1659x2212. Retinal fundus photograph. Remidio Fundus on Phone (FOP) camera
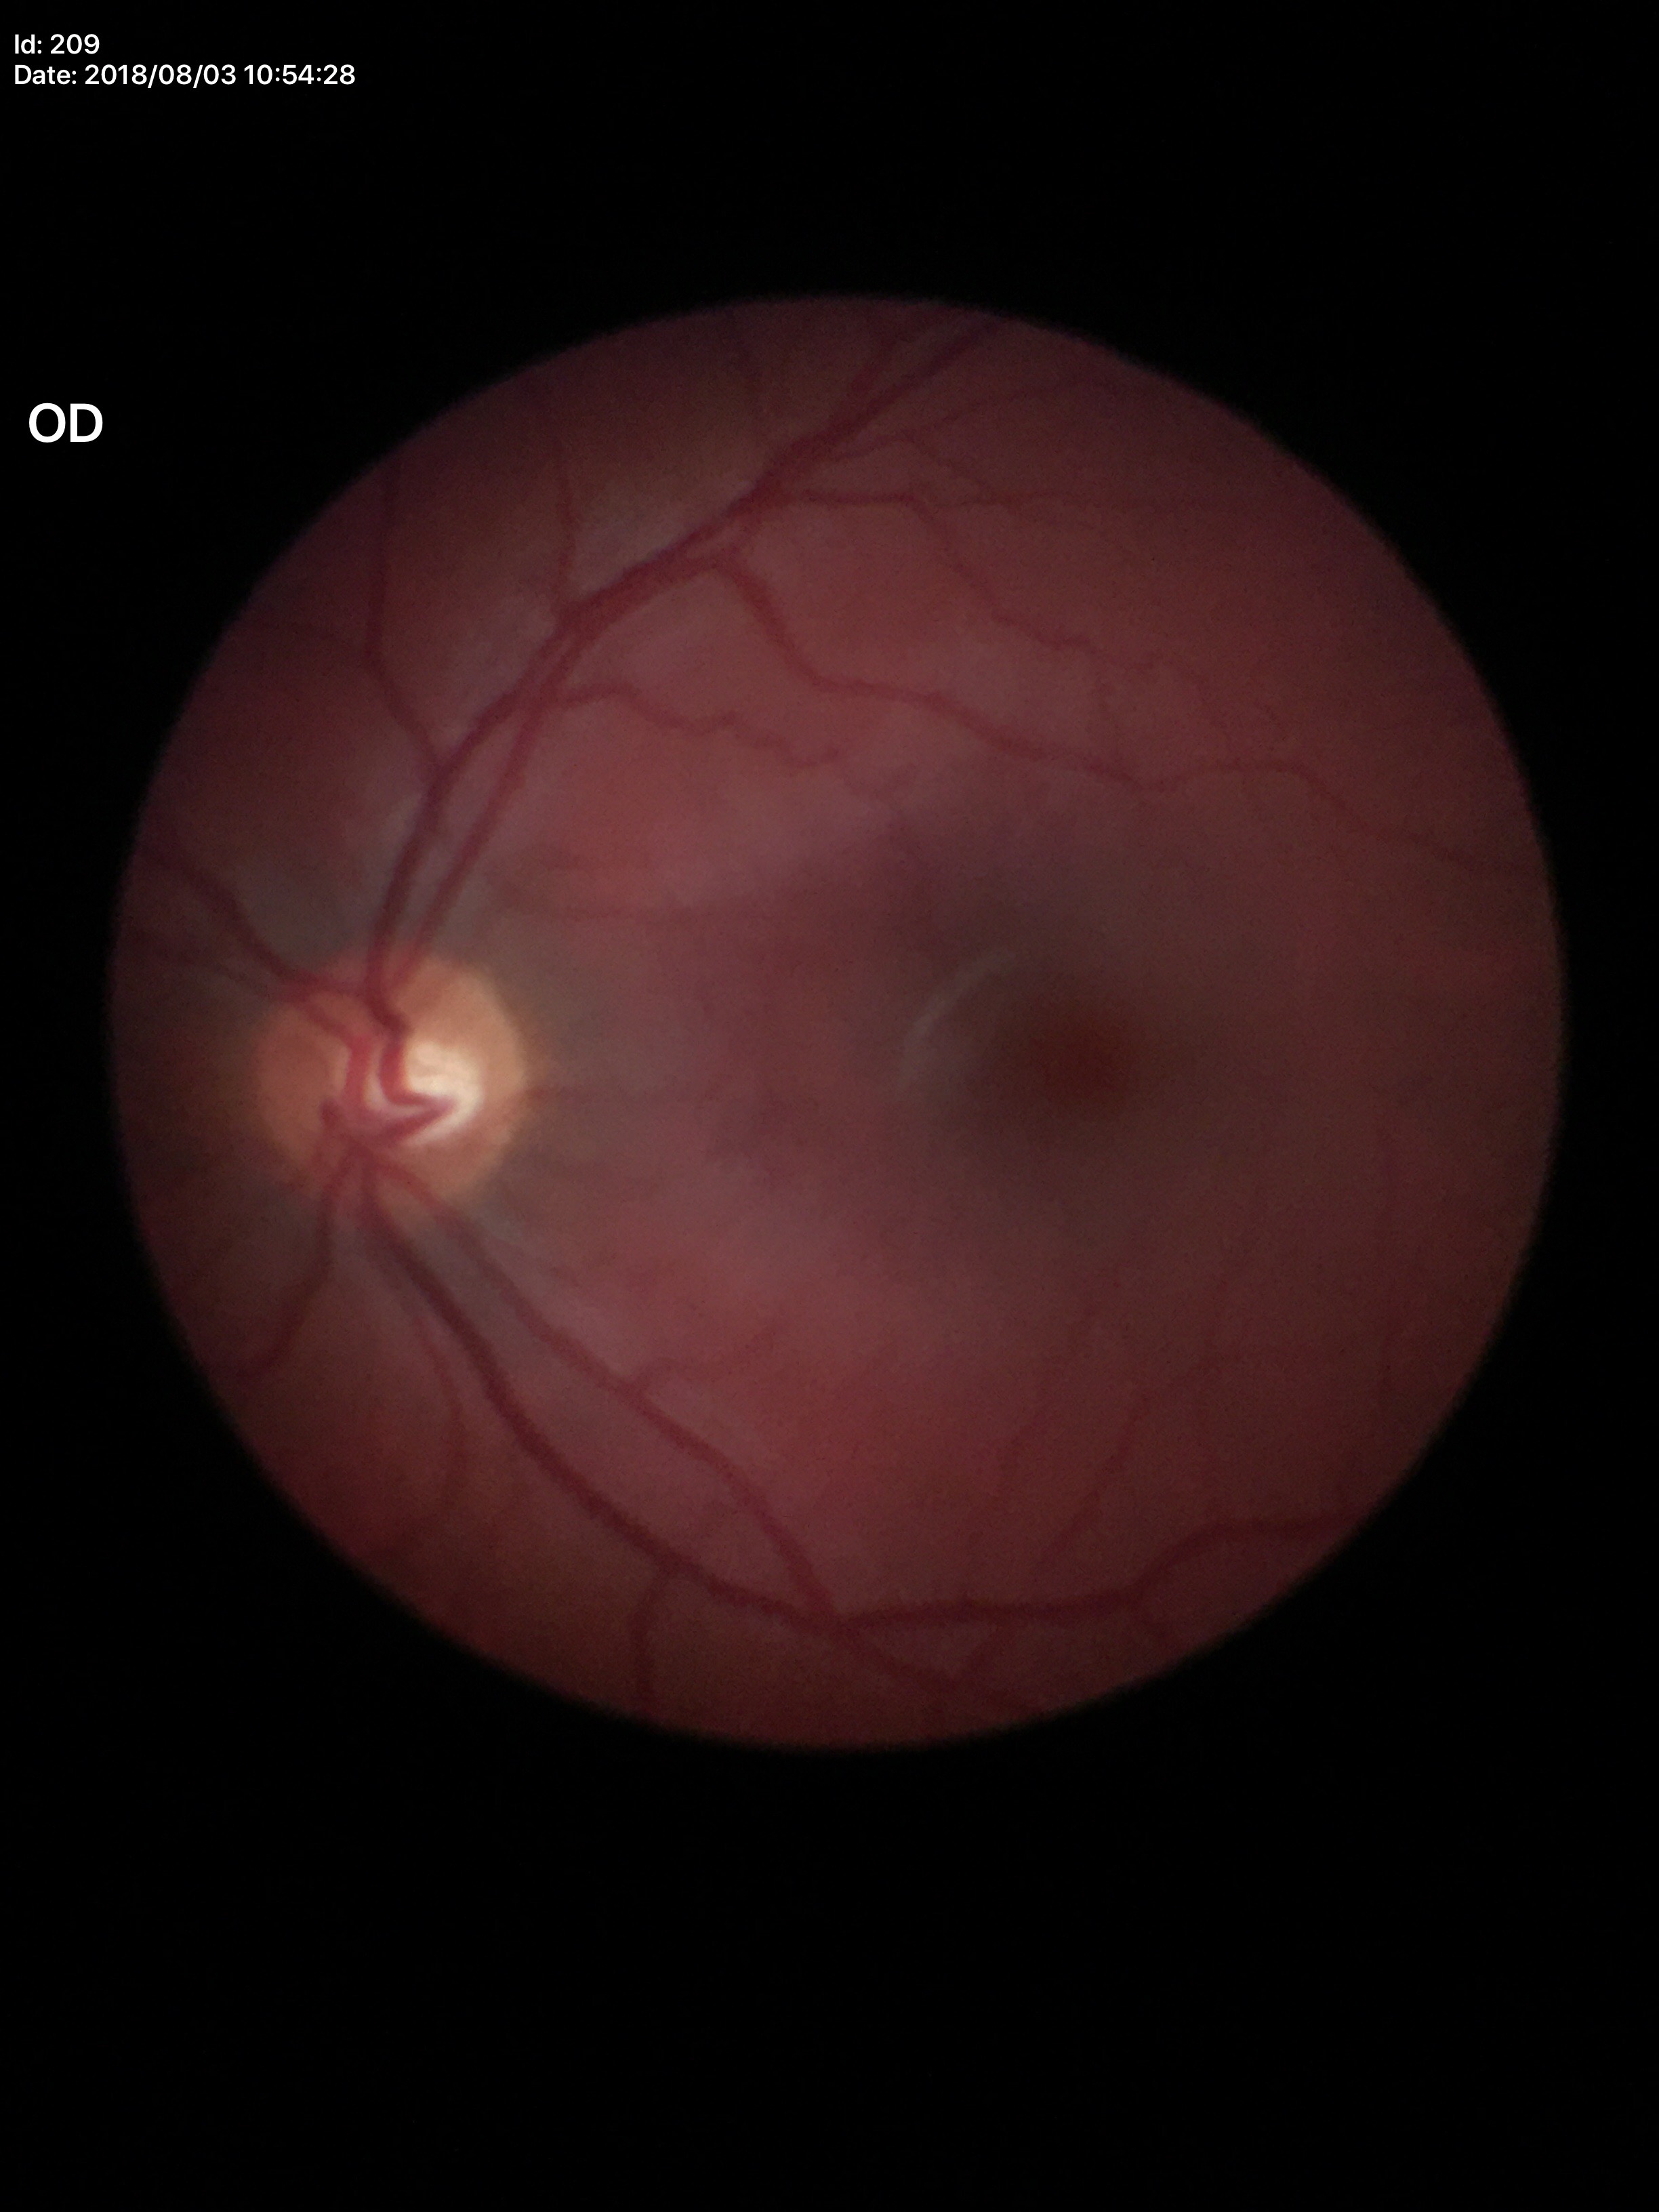
Q: Horizontal CDR?
A: 0.55
Q: What is the glaucoma assessment?
A: no suspicious findings (all 5 graders called normal)
Q: Vertical CDR?
A: 0.42